Image size 640x480. Wide-field contact fundus photograph of an infant. Camera: Clarity RetCam 3 (130° FOV): 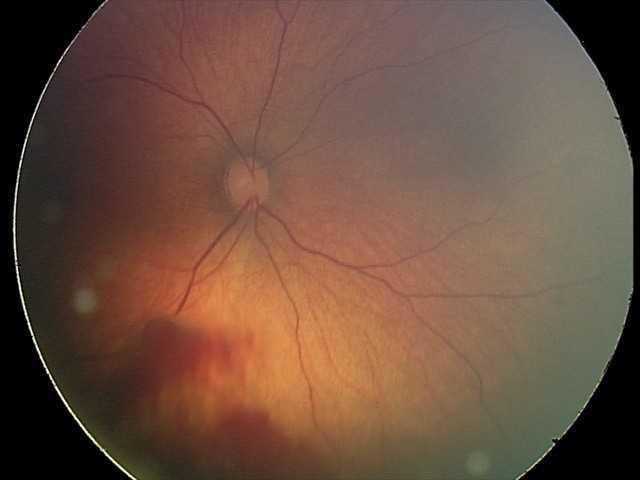 From an examination with diagnosis of retinal hemorrhages.